Color fundus photograph; image size 2352x1568:
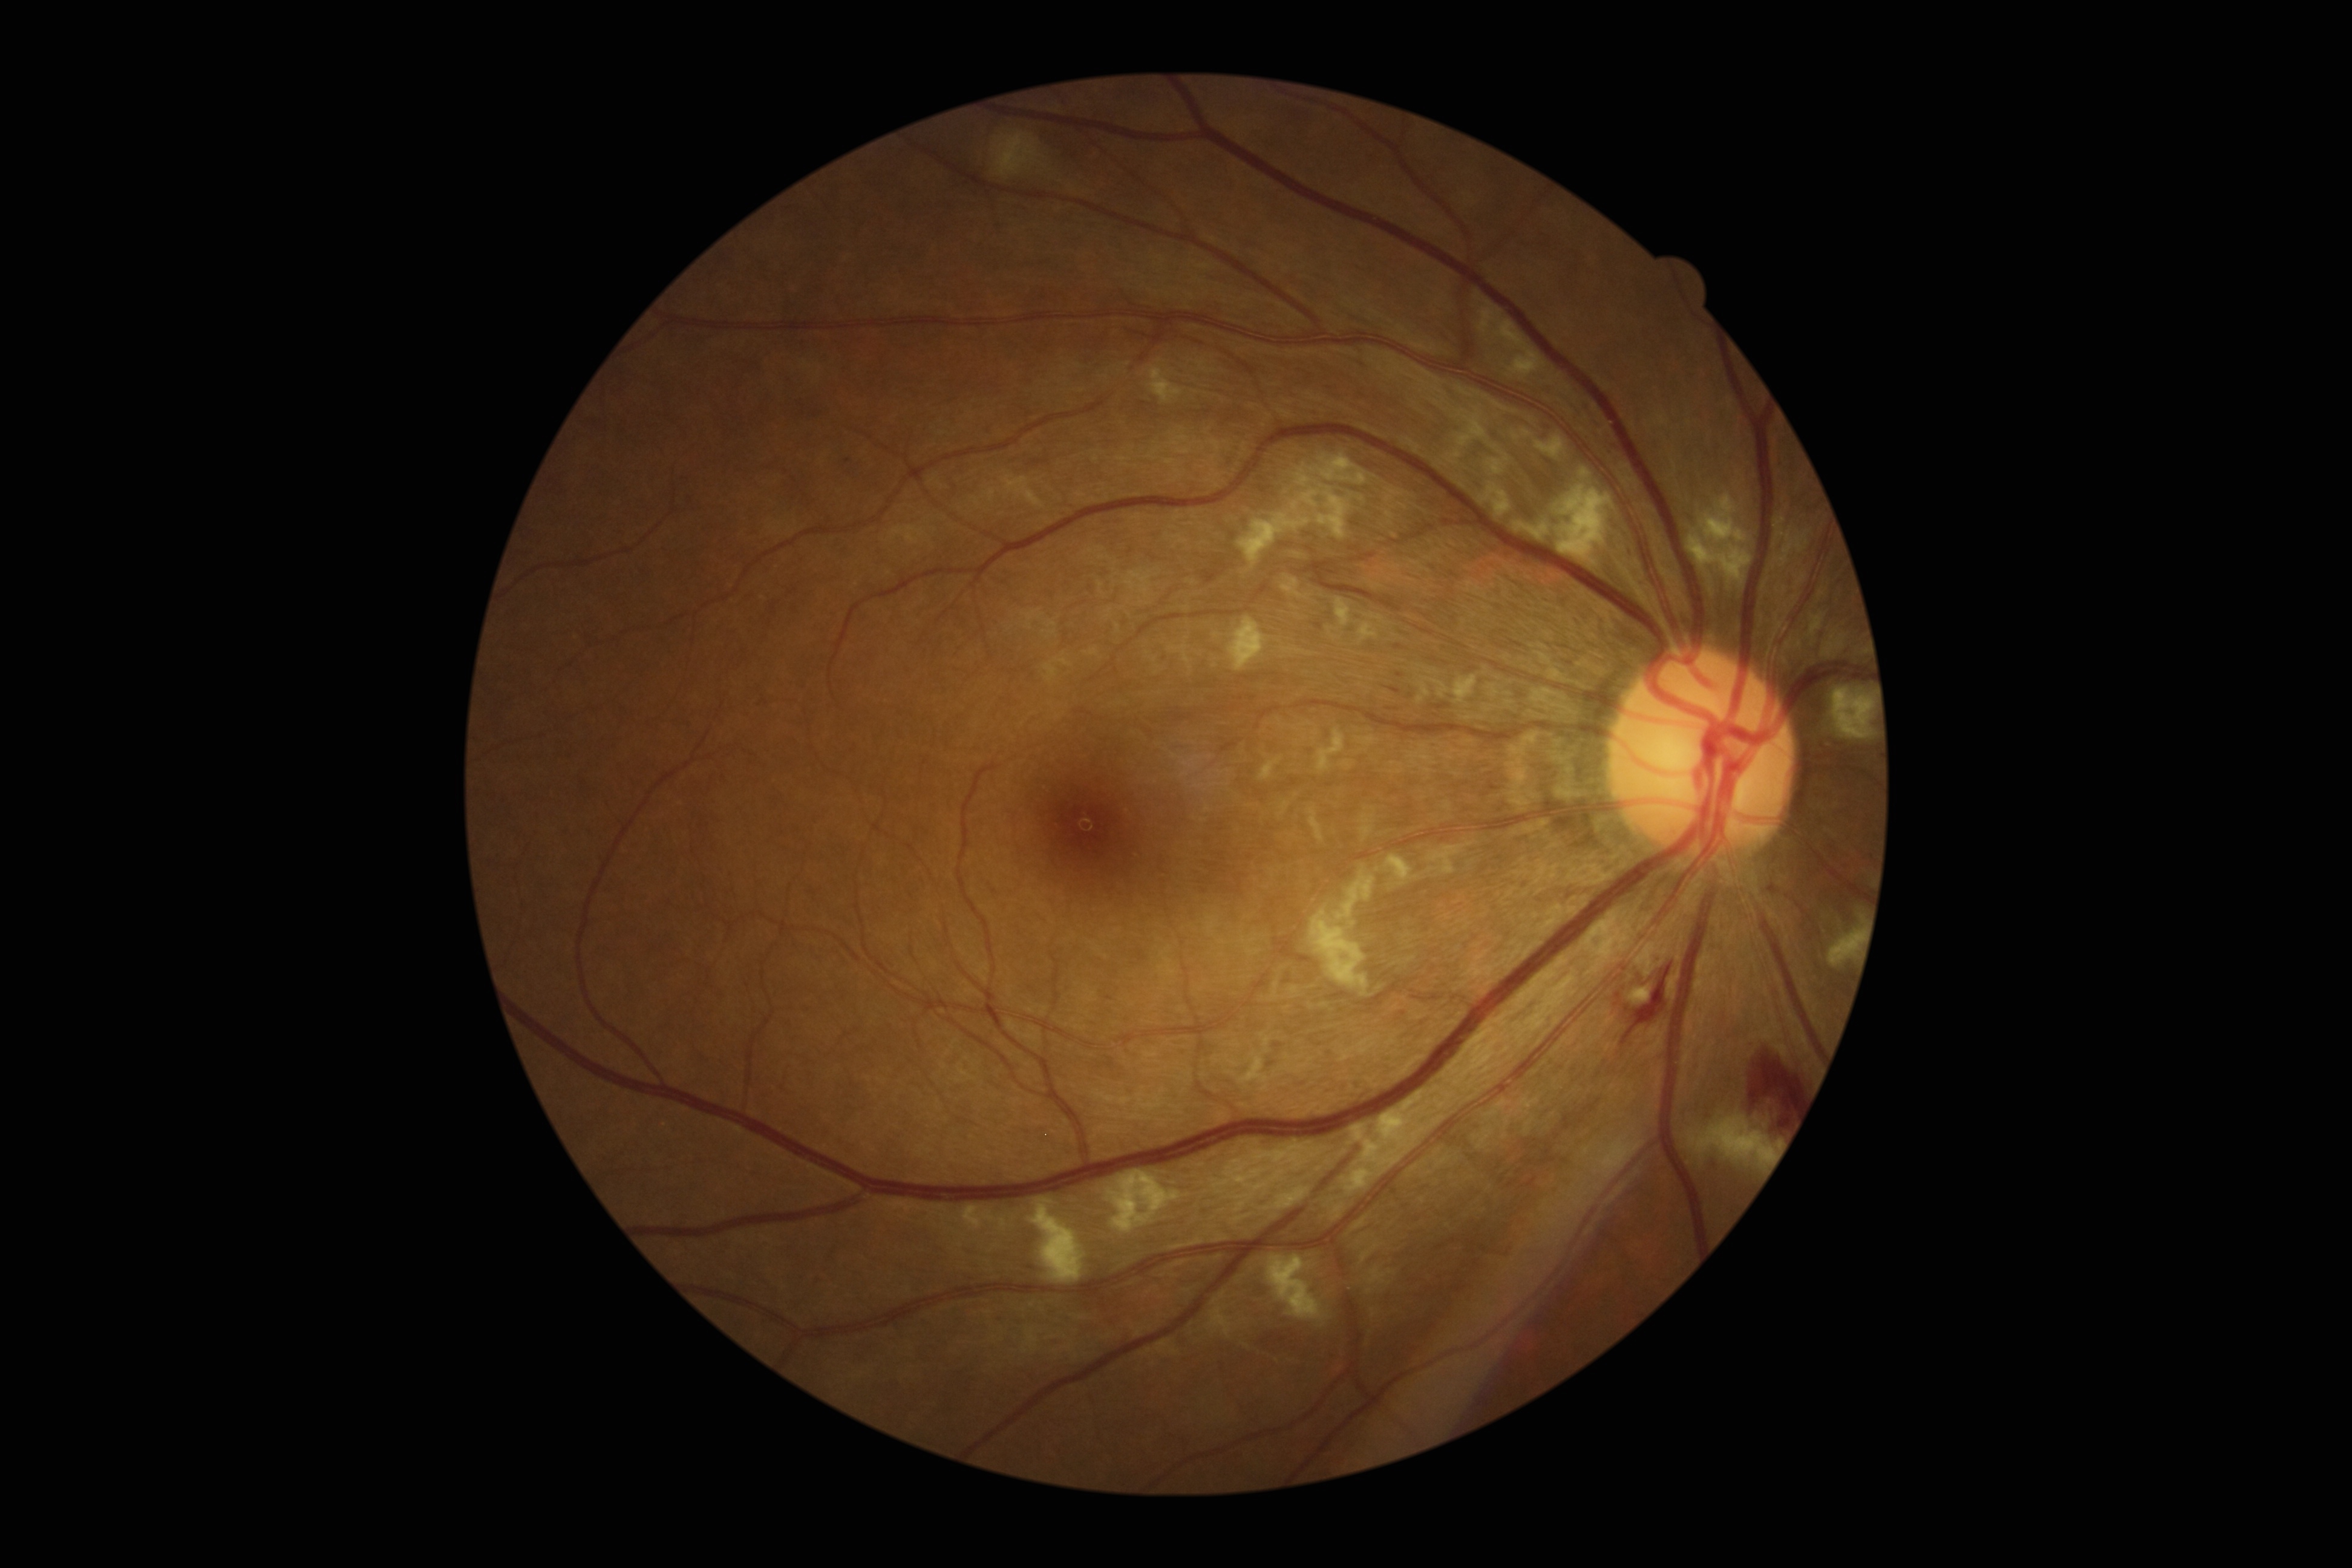
Findings:
- diabetic retinopathy (DR): grade 2